Color fundus photograph, 848 by 848 pixels, Davis DR grading, nonmydriatic fundus photograph
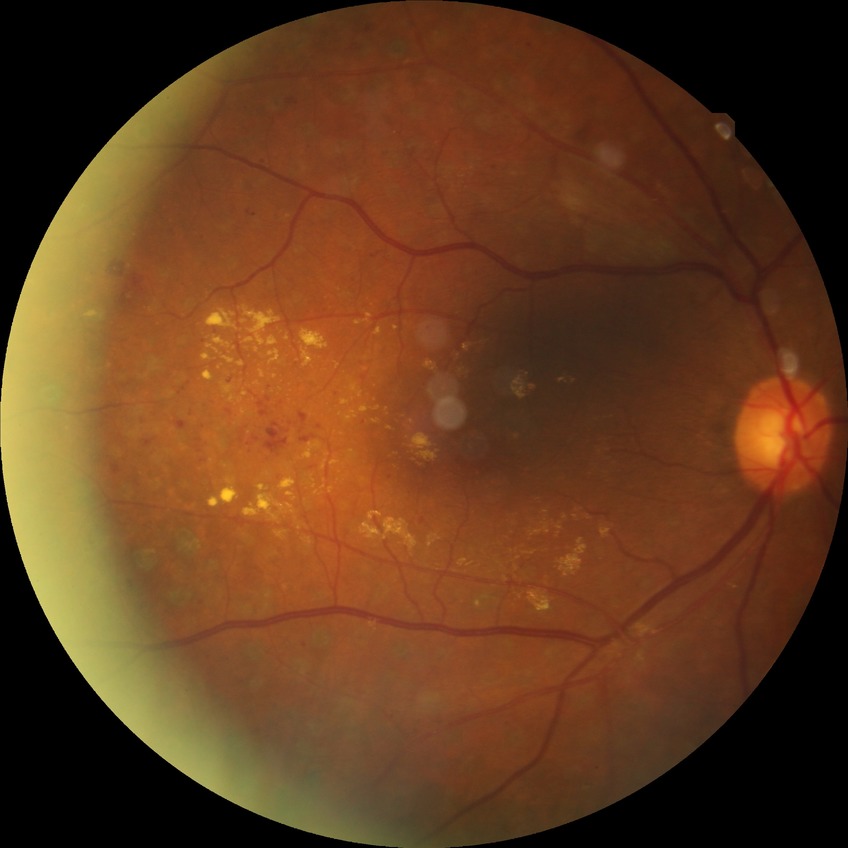 Modified Davis grading is proliferative diabetic retinopathy.